CFP — 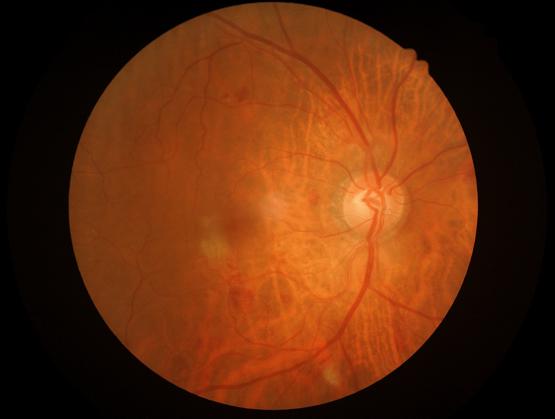
  illumination: even
  overall_quality: good